848x848:
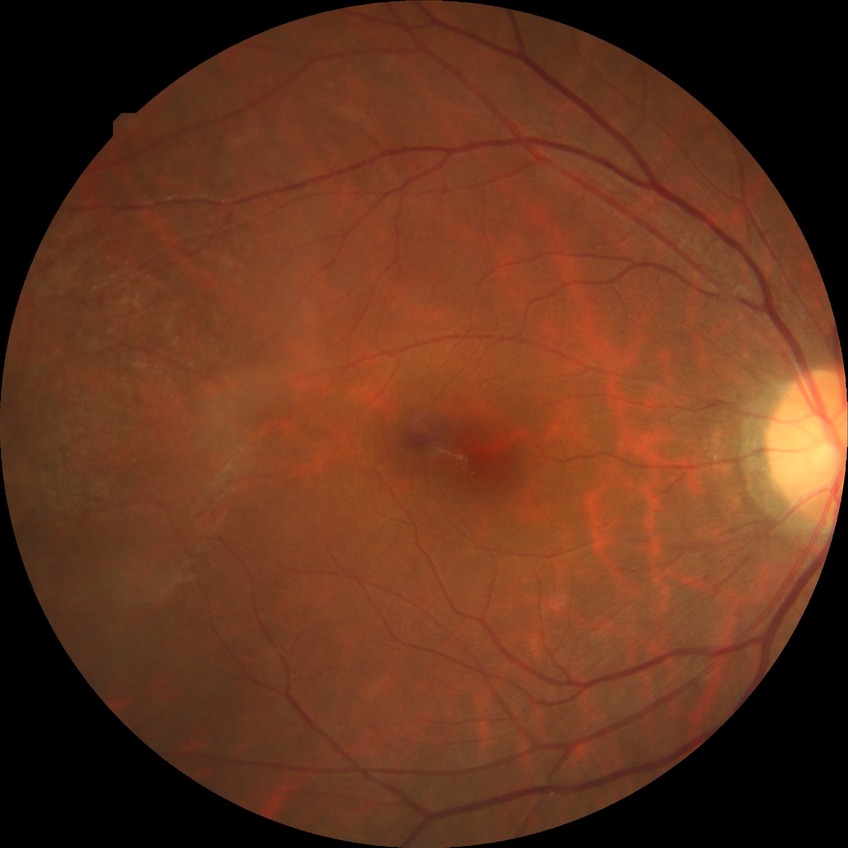
Assessment:
* diabetic retinopathy grade: no diabetic retinopathy